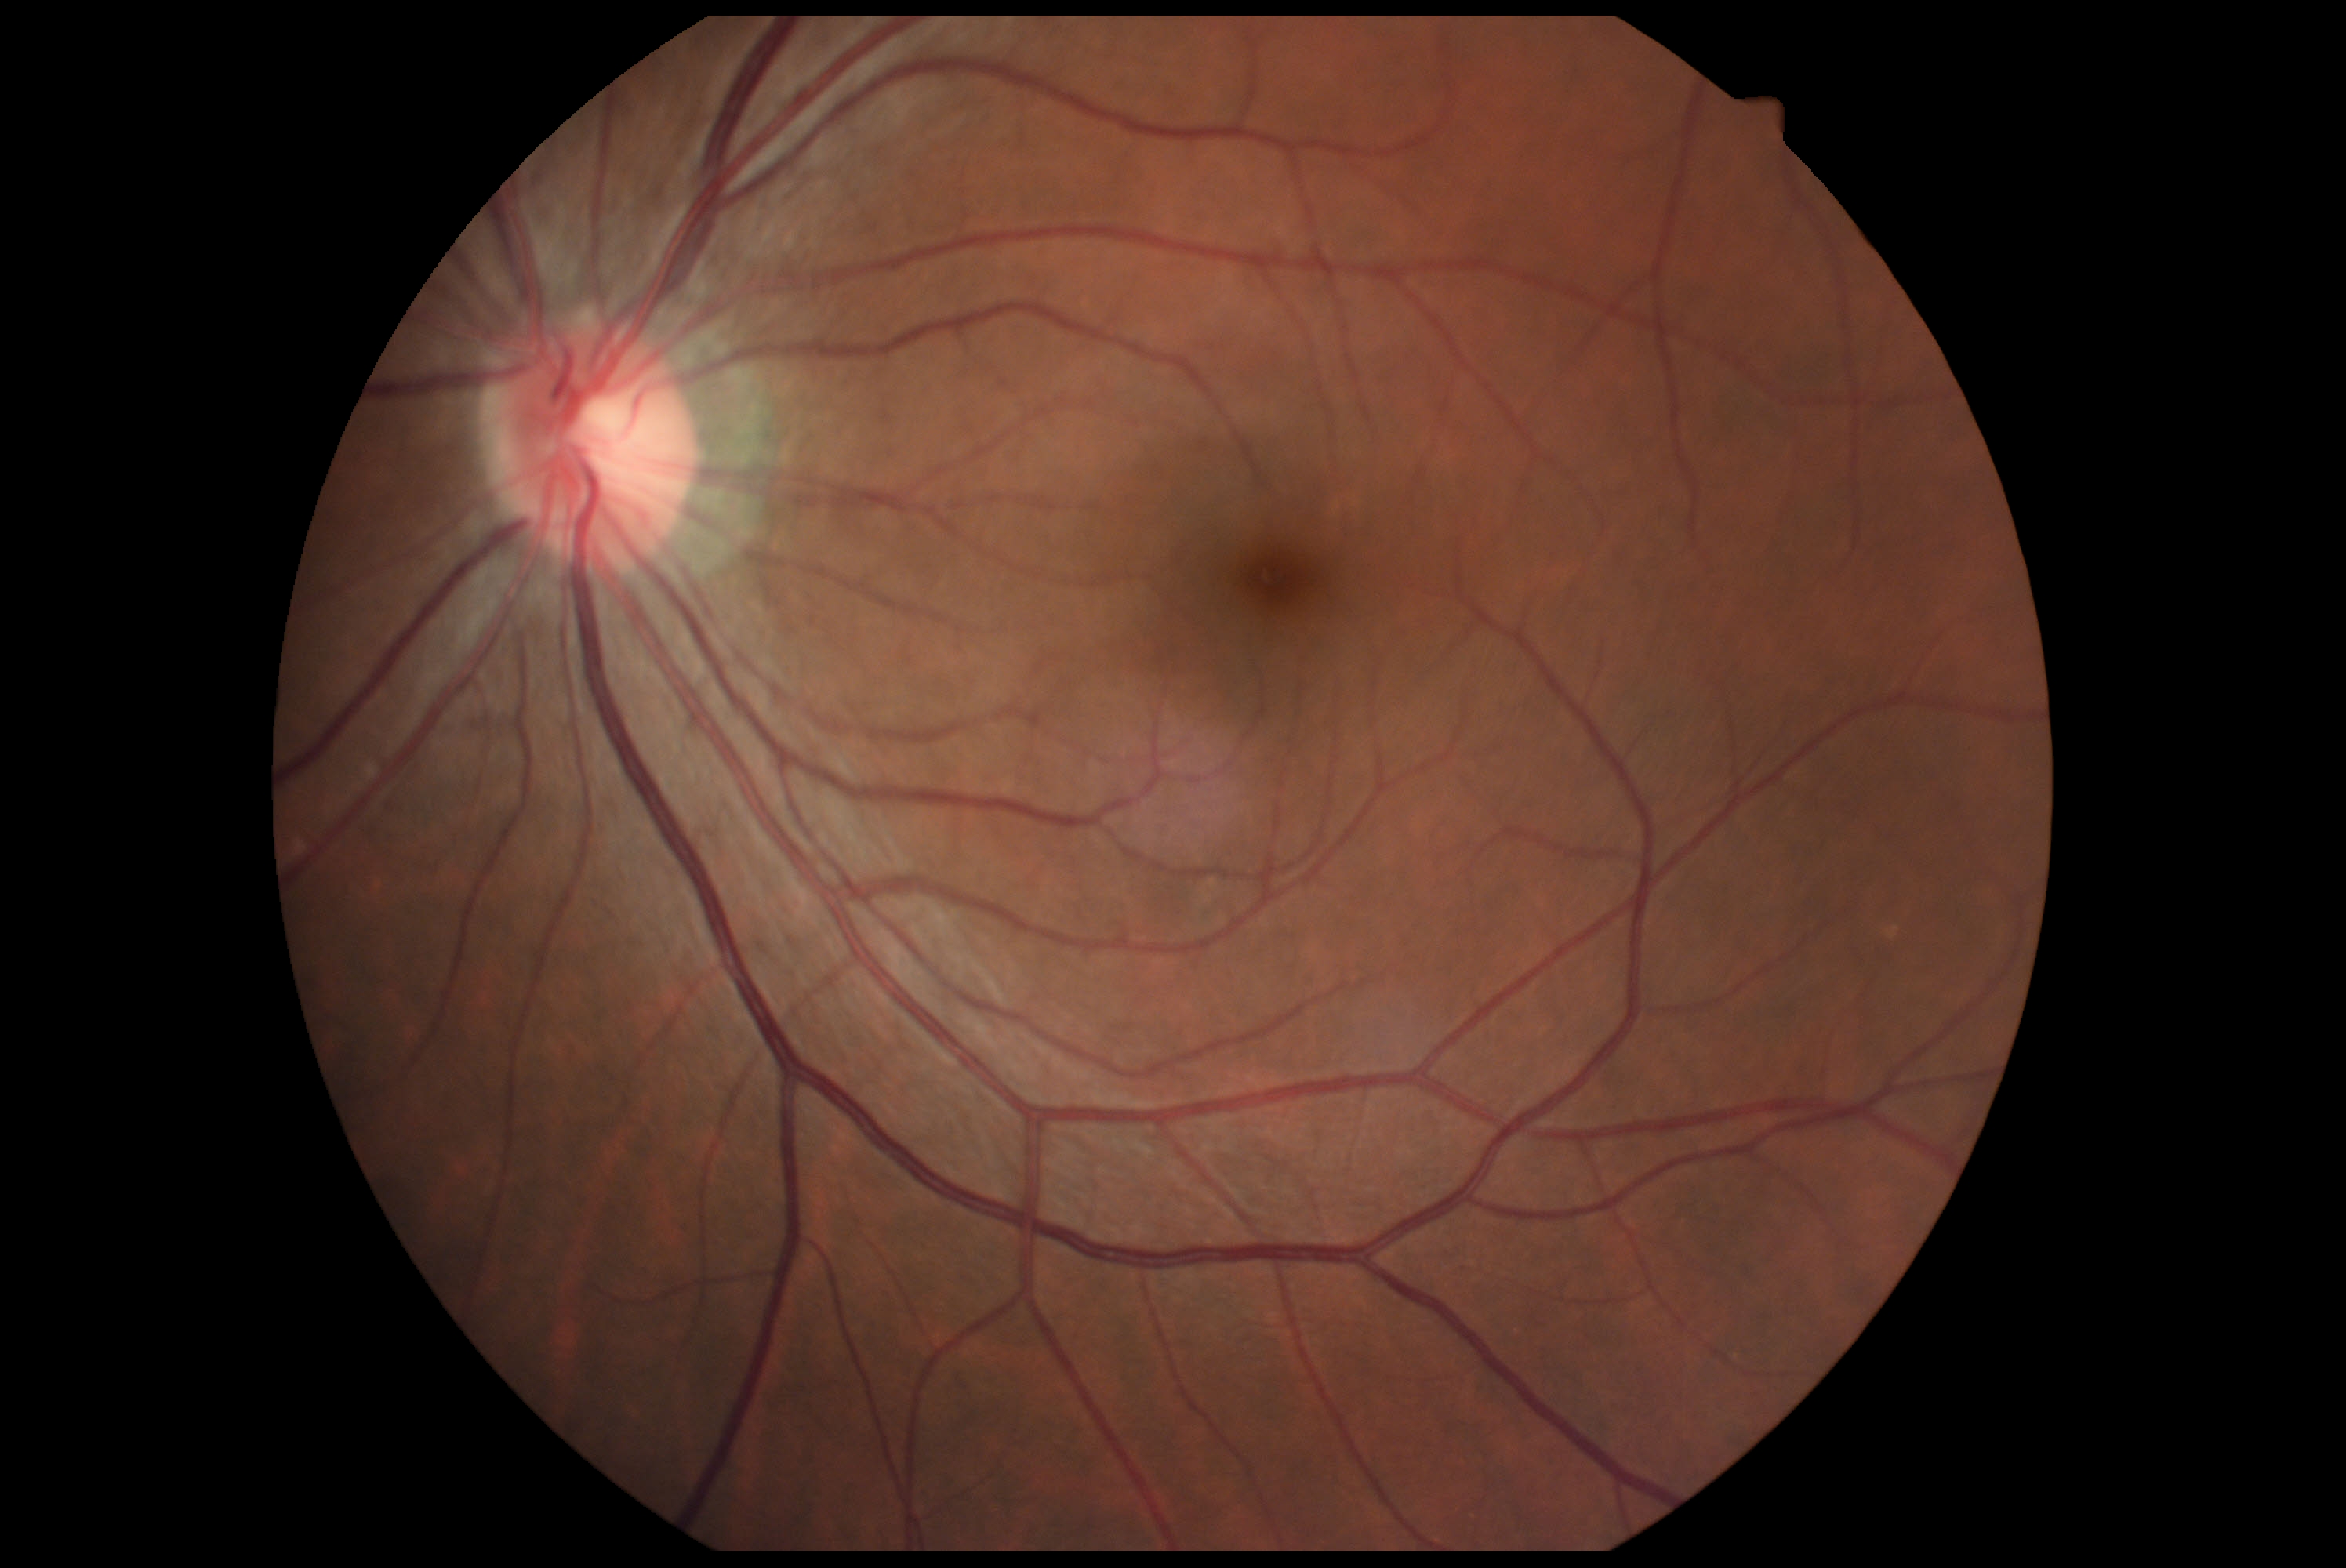

{
  "dr_grade": "grade 0 (no apparent retinopathy)"
}